45° FOV:
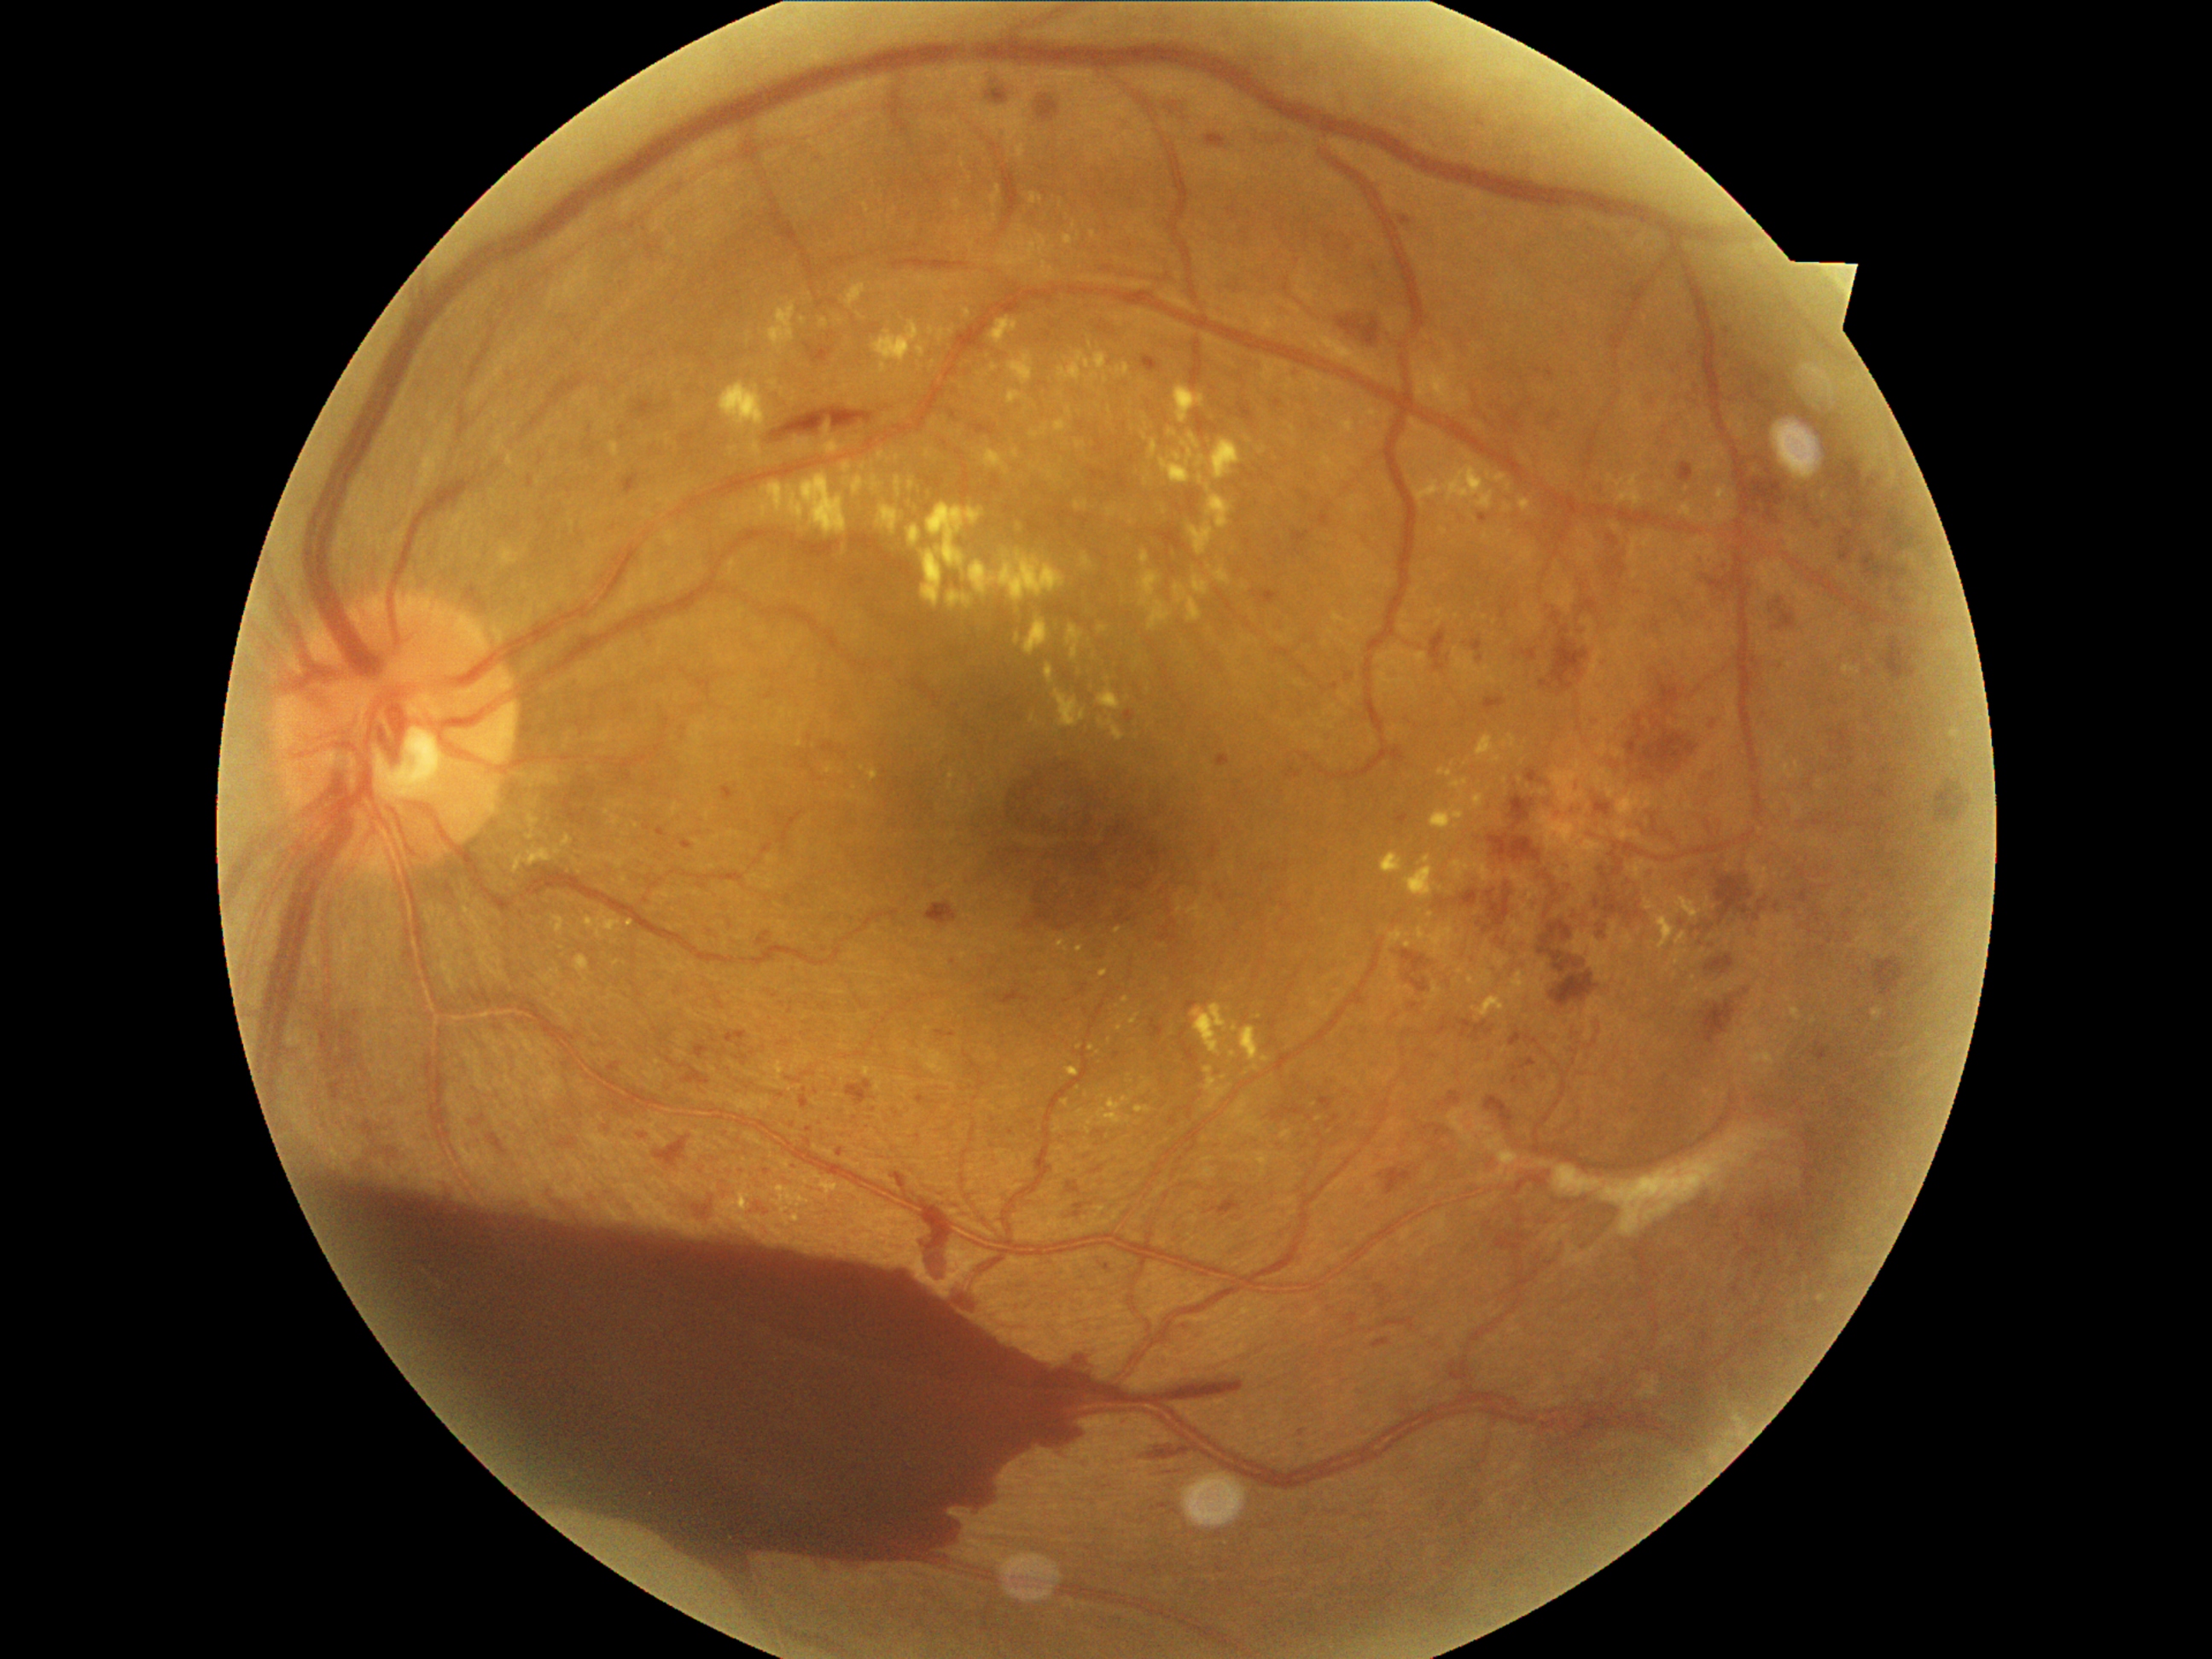 DR grade is 4 (PDR)
Representative lesions:
EXs (partial): (783, 1160, 791, 1170) | (1397, 986, 1402, 998) | (1520, 547, 1535, 566) | (1025, 615, 1051, 656) | (1477, 735, 1501, 764) | (528, 837, 538, 847) | (1382, 854, 1404, 875) | (825, 441, 839, 453) | (991, 185, 1001, 206) | (771, 380, 779, 388) | (929, 327, 934, 335) | (725, 515, 740, 523) | (1160, 441, 1196, 486) | (970, 549, 1066, 603)
Small EXs near x=1079, y=1048 | x=1132, y=523 | x=1409, y=945 | x=994, y=367 | x=1247, y=1071
MAs (partial): (1501, 607, 1510, 619) | (1841, 547, 1853, 561) | (1607, 557, 1627, 578) | (1402, 952, 1428, 974) | (1841, 537, 1846, 545) | (1583, 600, 1597, 610) | (1025, 897, 1052, 929) | (1798, 870, 1807, 878) | (1477, 656, 1484, 665) | (1723, 329, 1732, 339) | (1844, 530, 1856, 540) | (1484, 697, 1505, 711) | (1440, 1091, 1462, 1107) | (721, 786, 736, 801) | (1373, 1337, 1392, 1348)
Small MAs near x=1108, y=1269 | x=954, y=962 | x=767, y=1171 | x=1018, y=985 | x=1349, y=677